Infant wide-field fundus photograph.
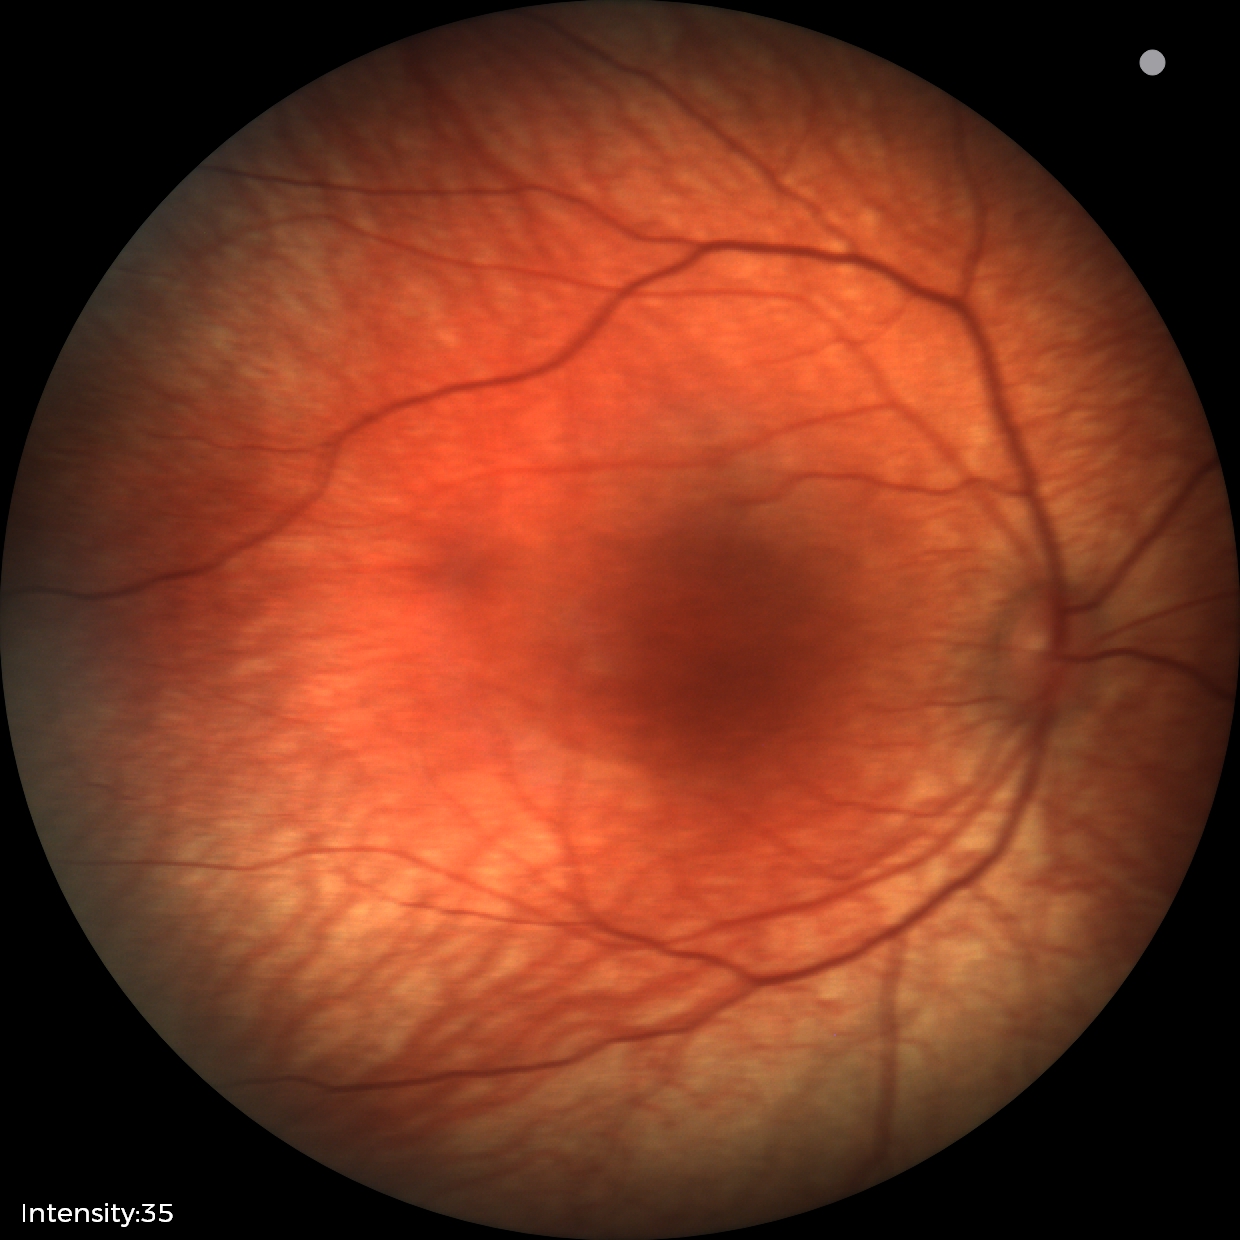

Normal screening examination.